Image size 2352x1568: 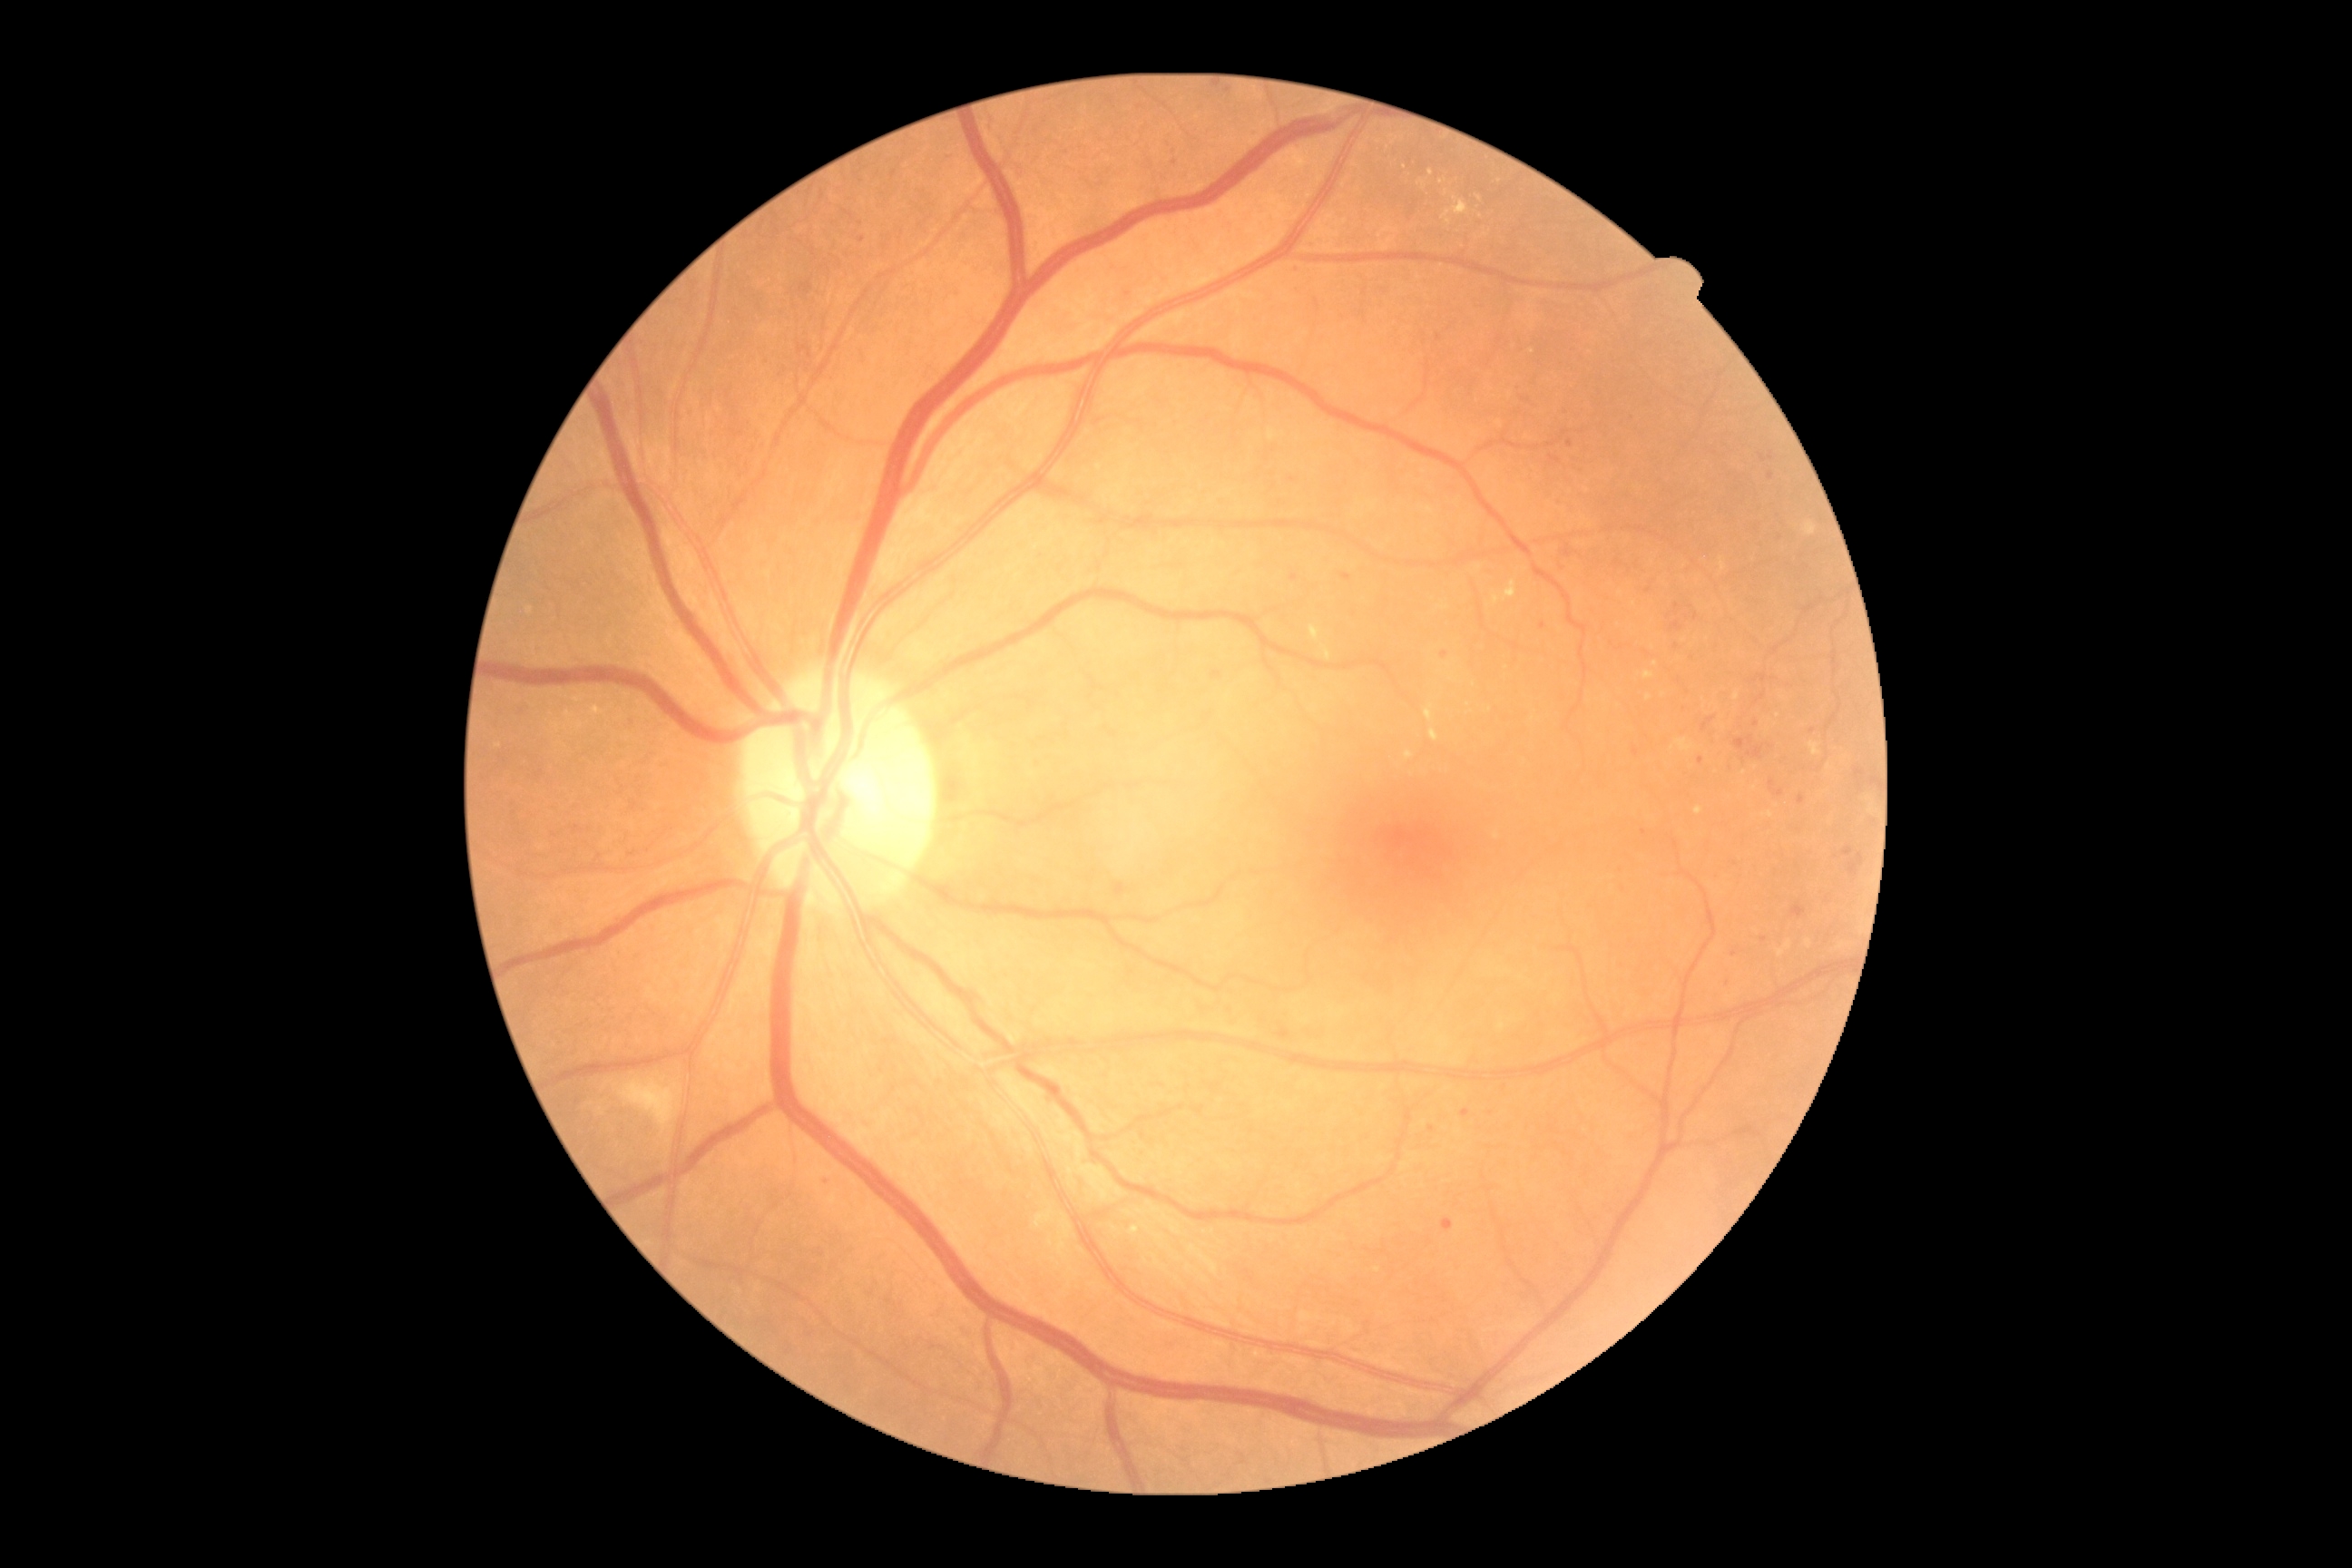

partial: true
dr_grade: 2
dr_grade_name: moderate NPDR
lesions:
  ex:
    - x1=1442 y1=197 x2=1469 y2=219
    - x1=1676 y1=740 x2=1694 y2=752
    - x1=1311 y1=627 x2=1320 y2=642
    - x1=1805 y1=939 x2=1812 y2=948
    - x1=1391 y1=137 x2=1398 y2=146
    - x1=1643 y1=671 x2=1654 y2=681
    - x1=1431 y1=729 x2=1438 y2=741
  ex_small_approx:
    - (1432; 173)
    - (1447; 193)
    - (1393; 137)
    - (1829; 767)
    - (1445; 609)
    - (1448; 223)
  ma:
    - x1=1551 y1=455 x2=1562 y2=464
    - x1=1213 y1=671 x2=1222 y2=680
    - x1=1776 y1=790 x2=1785 y2=798
    - x1=1279 y1=1030 x2=1291 y2=1041
    - x1=1747 y1=747 x2=1765 y2=760
    - x1=825 y1=1175 x2=832 y2=1184
    - x1=1563 y1=547 x2=1571 y2=558
  ma_small_approx:
    - (1570; 443)
    - (1445; 655)
    - (1677; 606)
    - (1813; 731)
    - (1128; 295)
    - (1228; 91)
    - (1432; 1129)